Nonmydriatic; camera: NIDEK AFC-230; image size 848x848; fundus photo; 45° field of view:
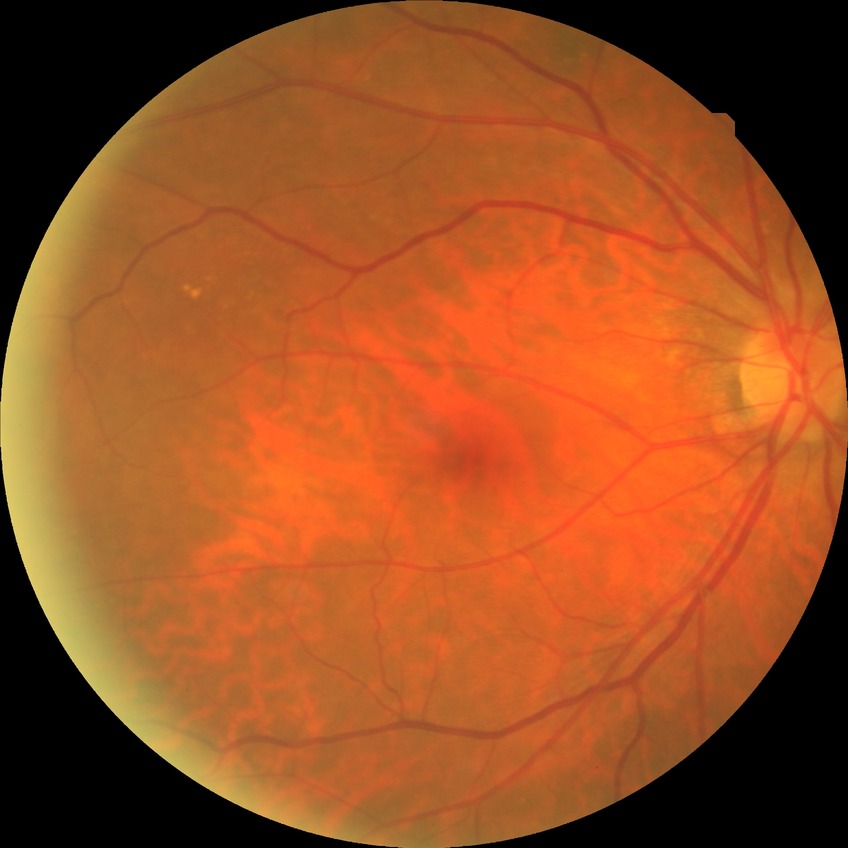

Modified Davis grade is NDR.